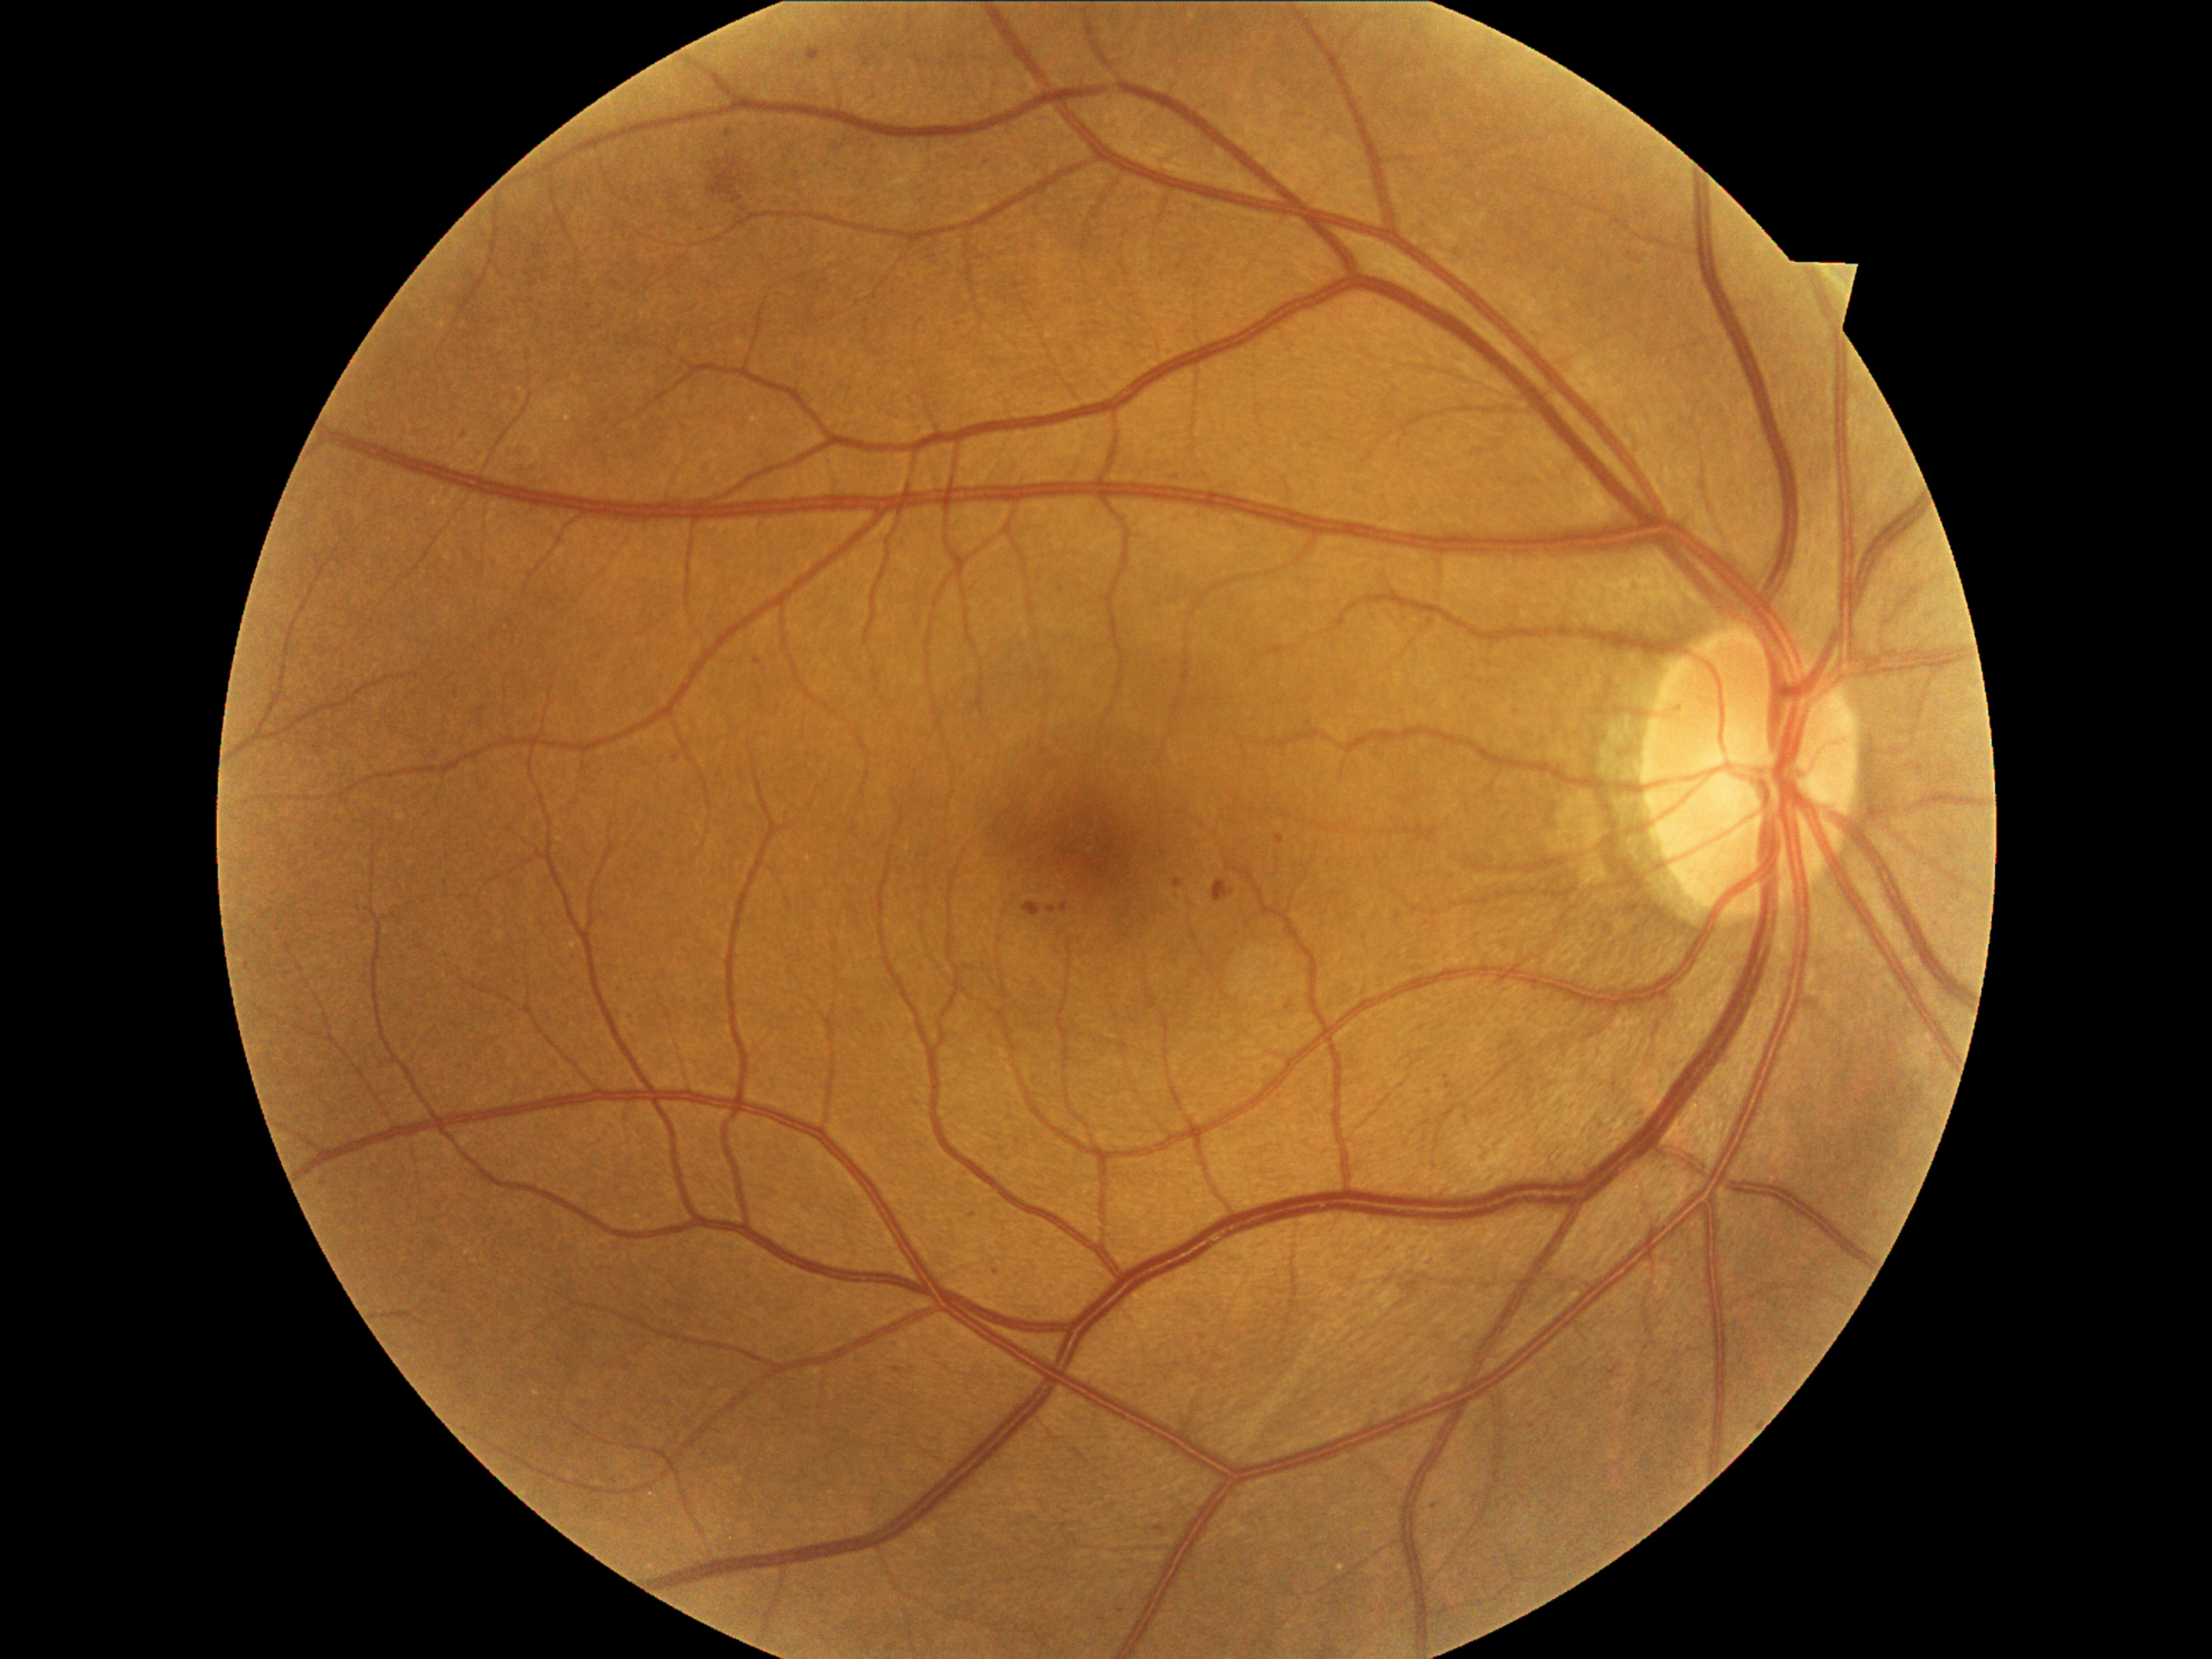 dr_grade: 2
lesions:
  se: []
  ma:
    - (1023,902,1042,917)
    - (1213,880,1235,902)
    - (1276,834,1286,844)
    - (1047,905,1057,912)
    - (1173,880,1182,888)
    - (894,1368,902,1373)
    - (992,1266,1001,1274)
    - (726,129,731,139)
    - (1447,1083,1455,1088)
    - (754,658,760,667)
    - (1155,1525,1163,1534)
    - (806,49,822,64)
    - (1061,904,1068,912)
  ma_small_centers:
    - x=1434 y=1507
    - x=973 y=1216
    - x=1876 y=1216
    - x=676 y=757
    - x=599 y=658
  ex: []
  he:
    - (707,160,745,204)